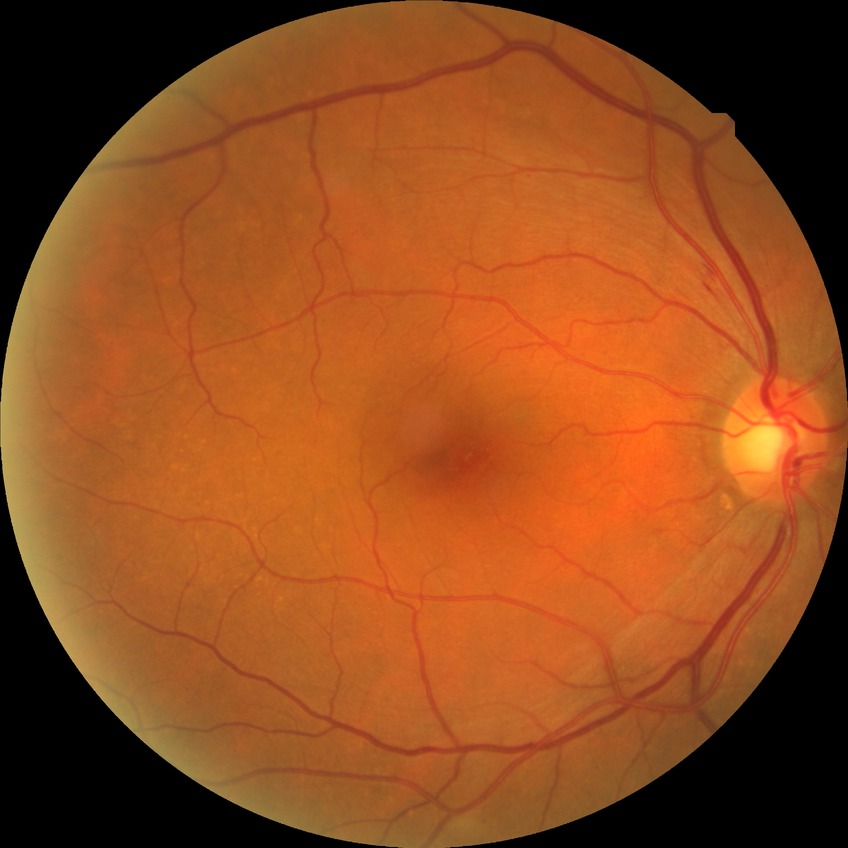

diabetic retinopathy stage = no diabetic retinopathy.